FOV: 45 degrees.
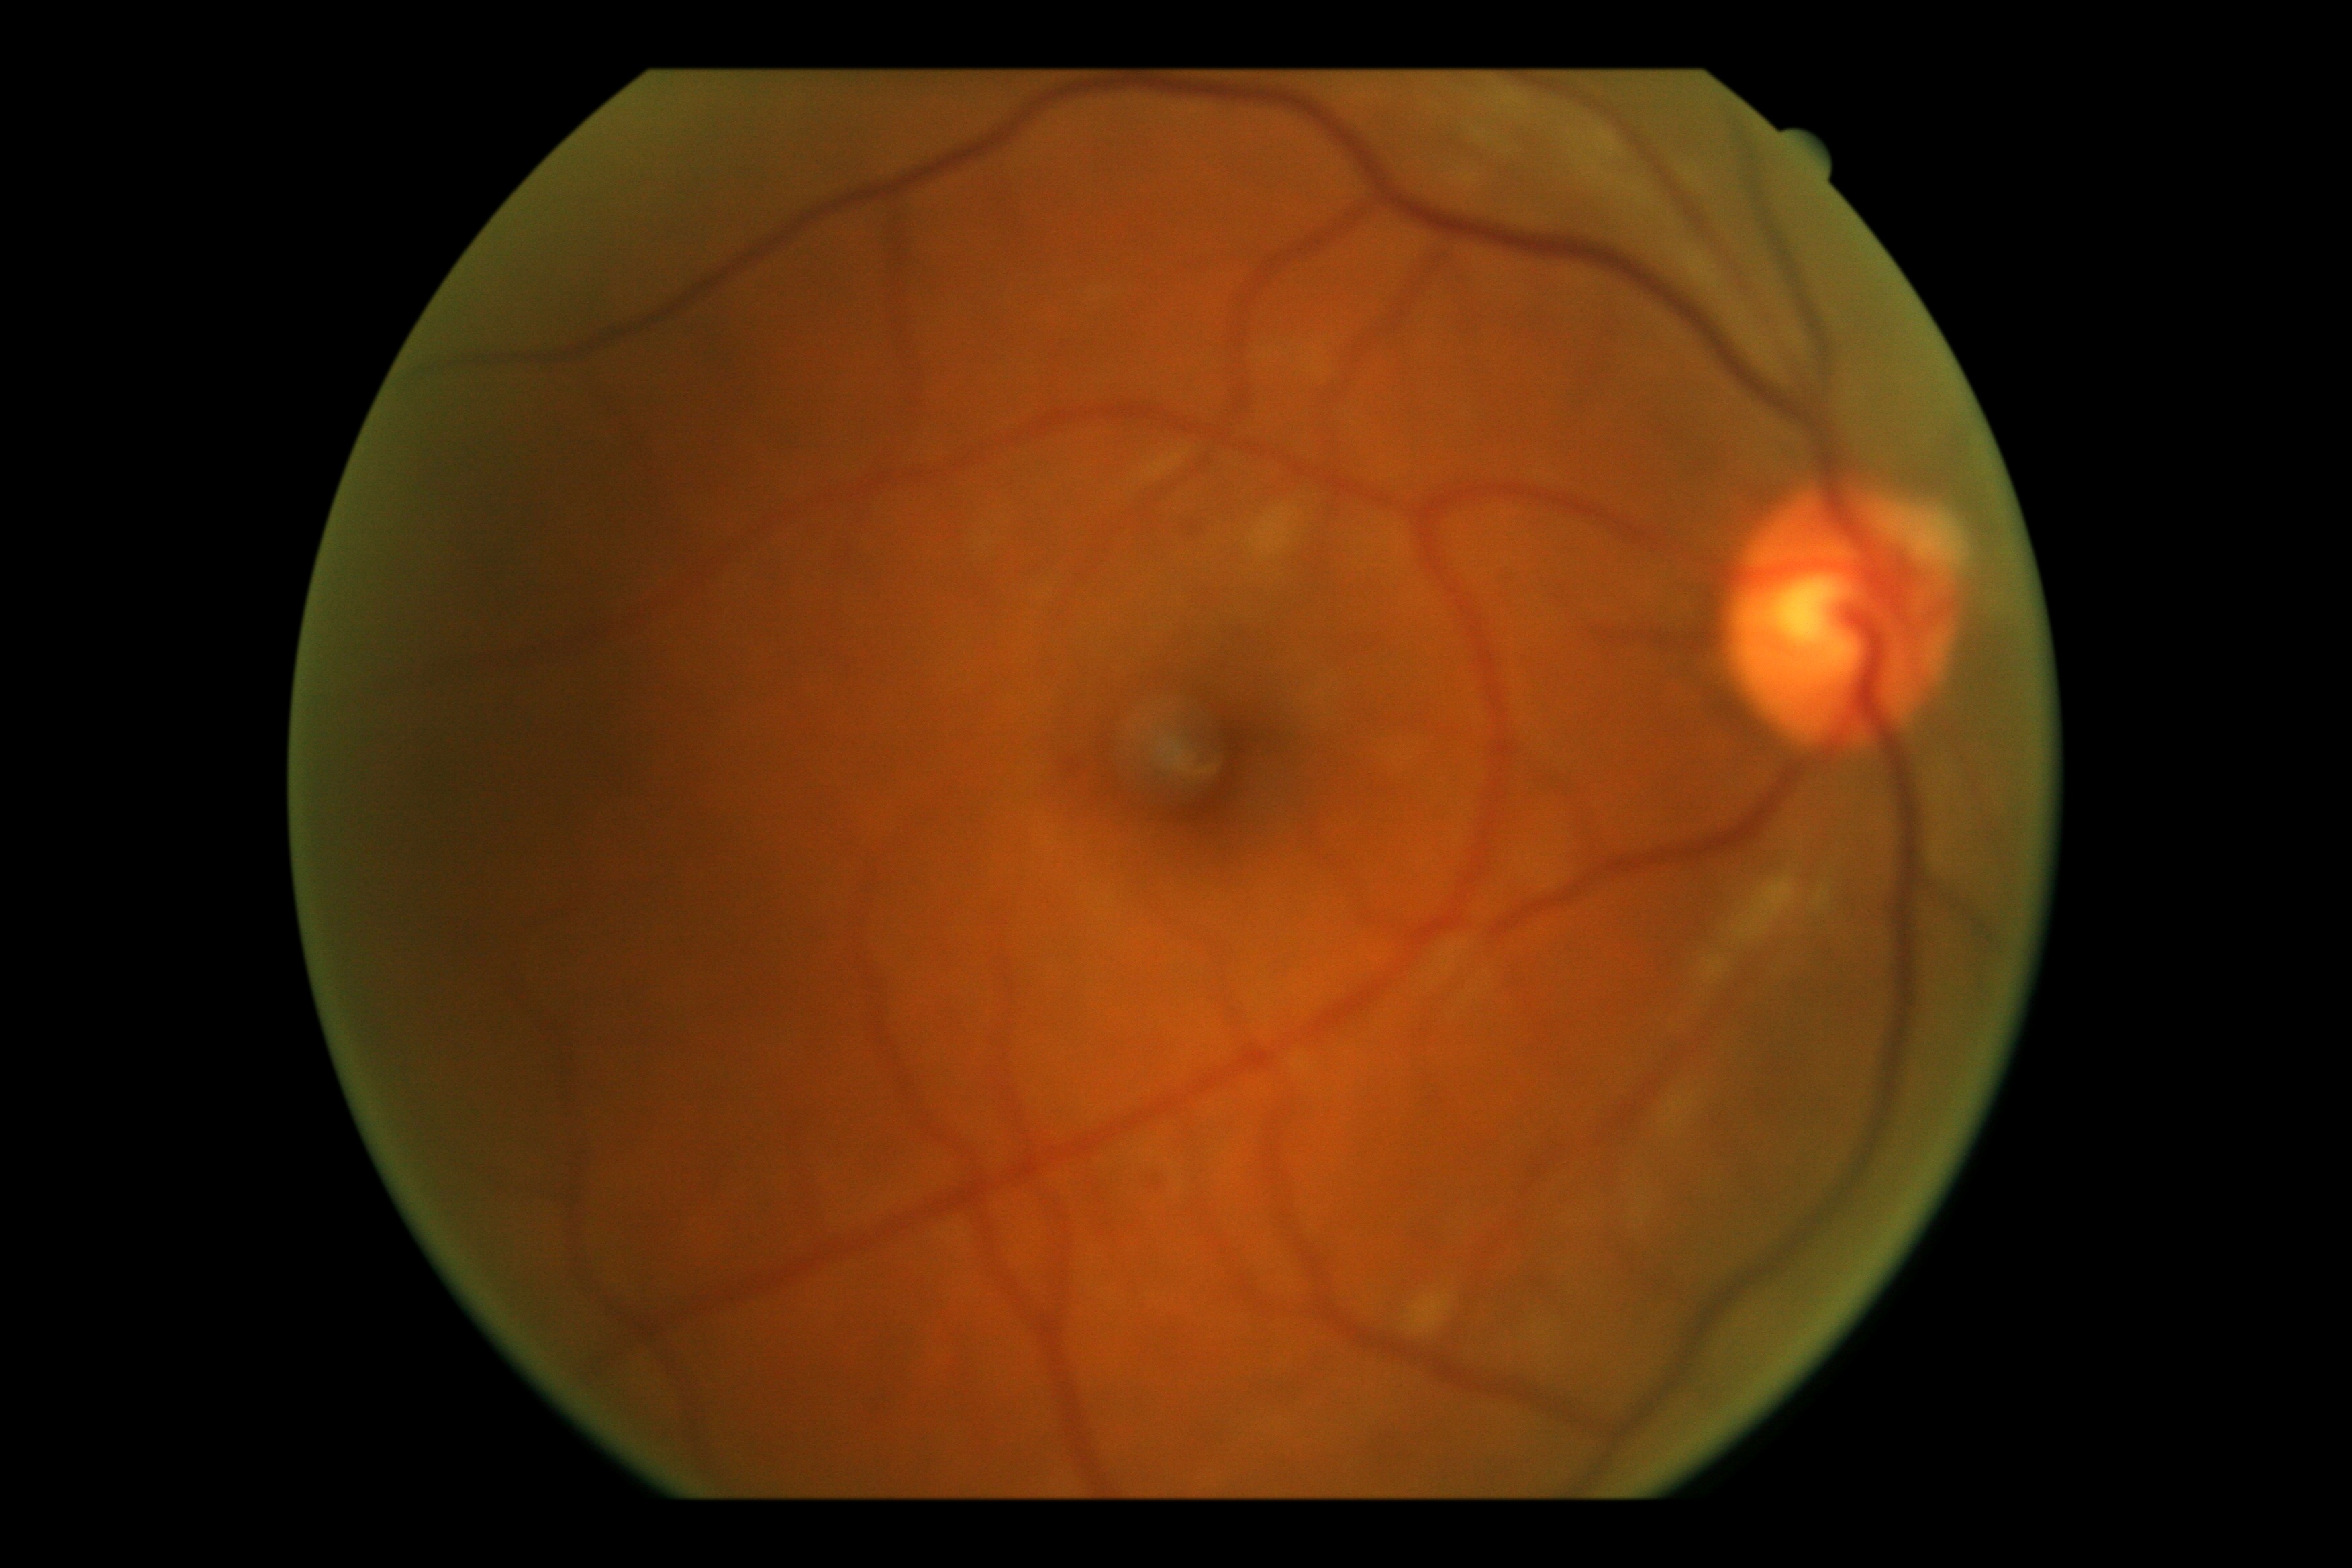

DR stage = grade 2 (moderate NPDR).